Fundus photo. Image size 2352x1568.
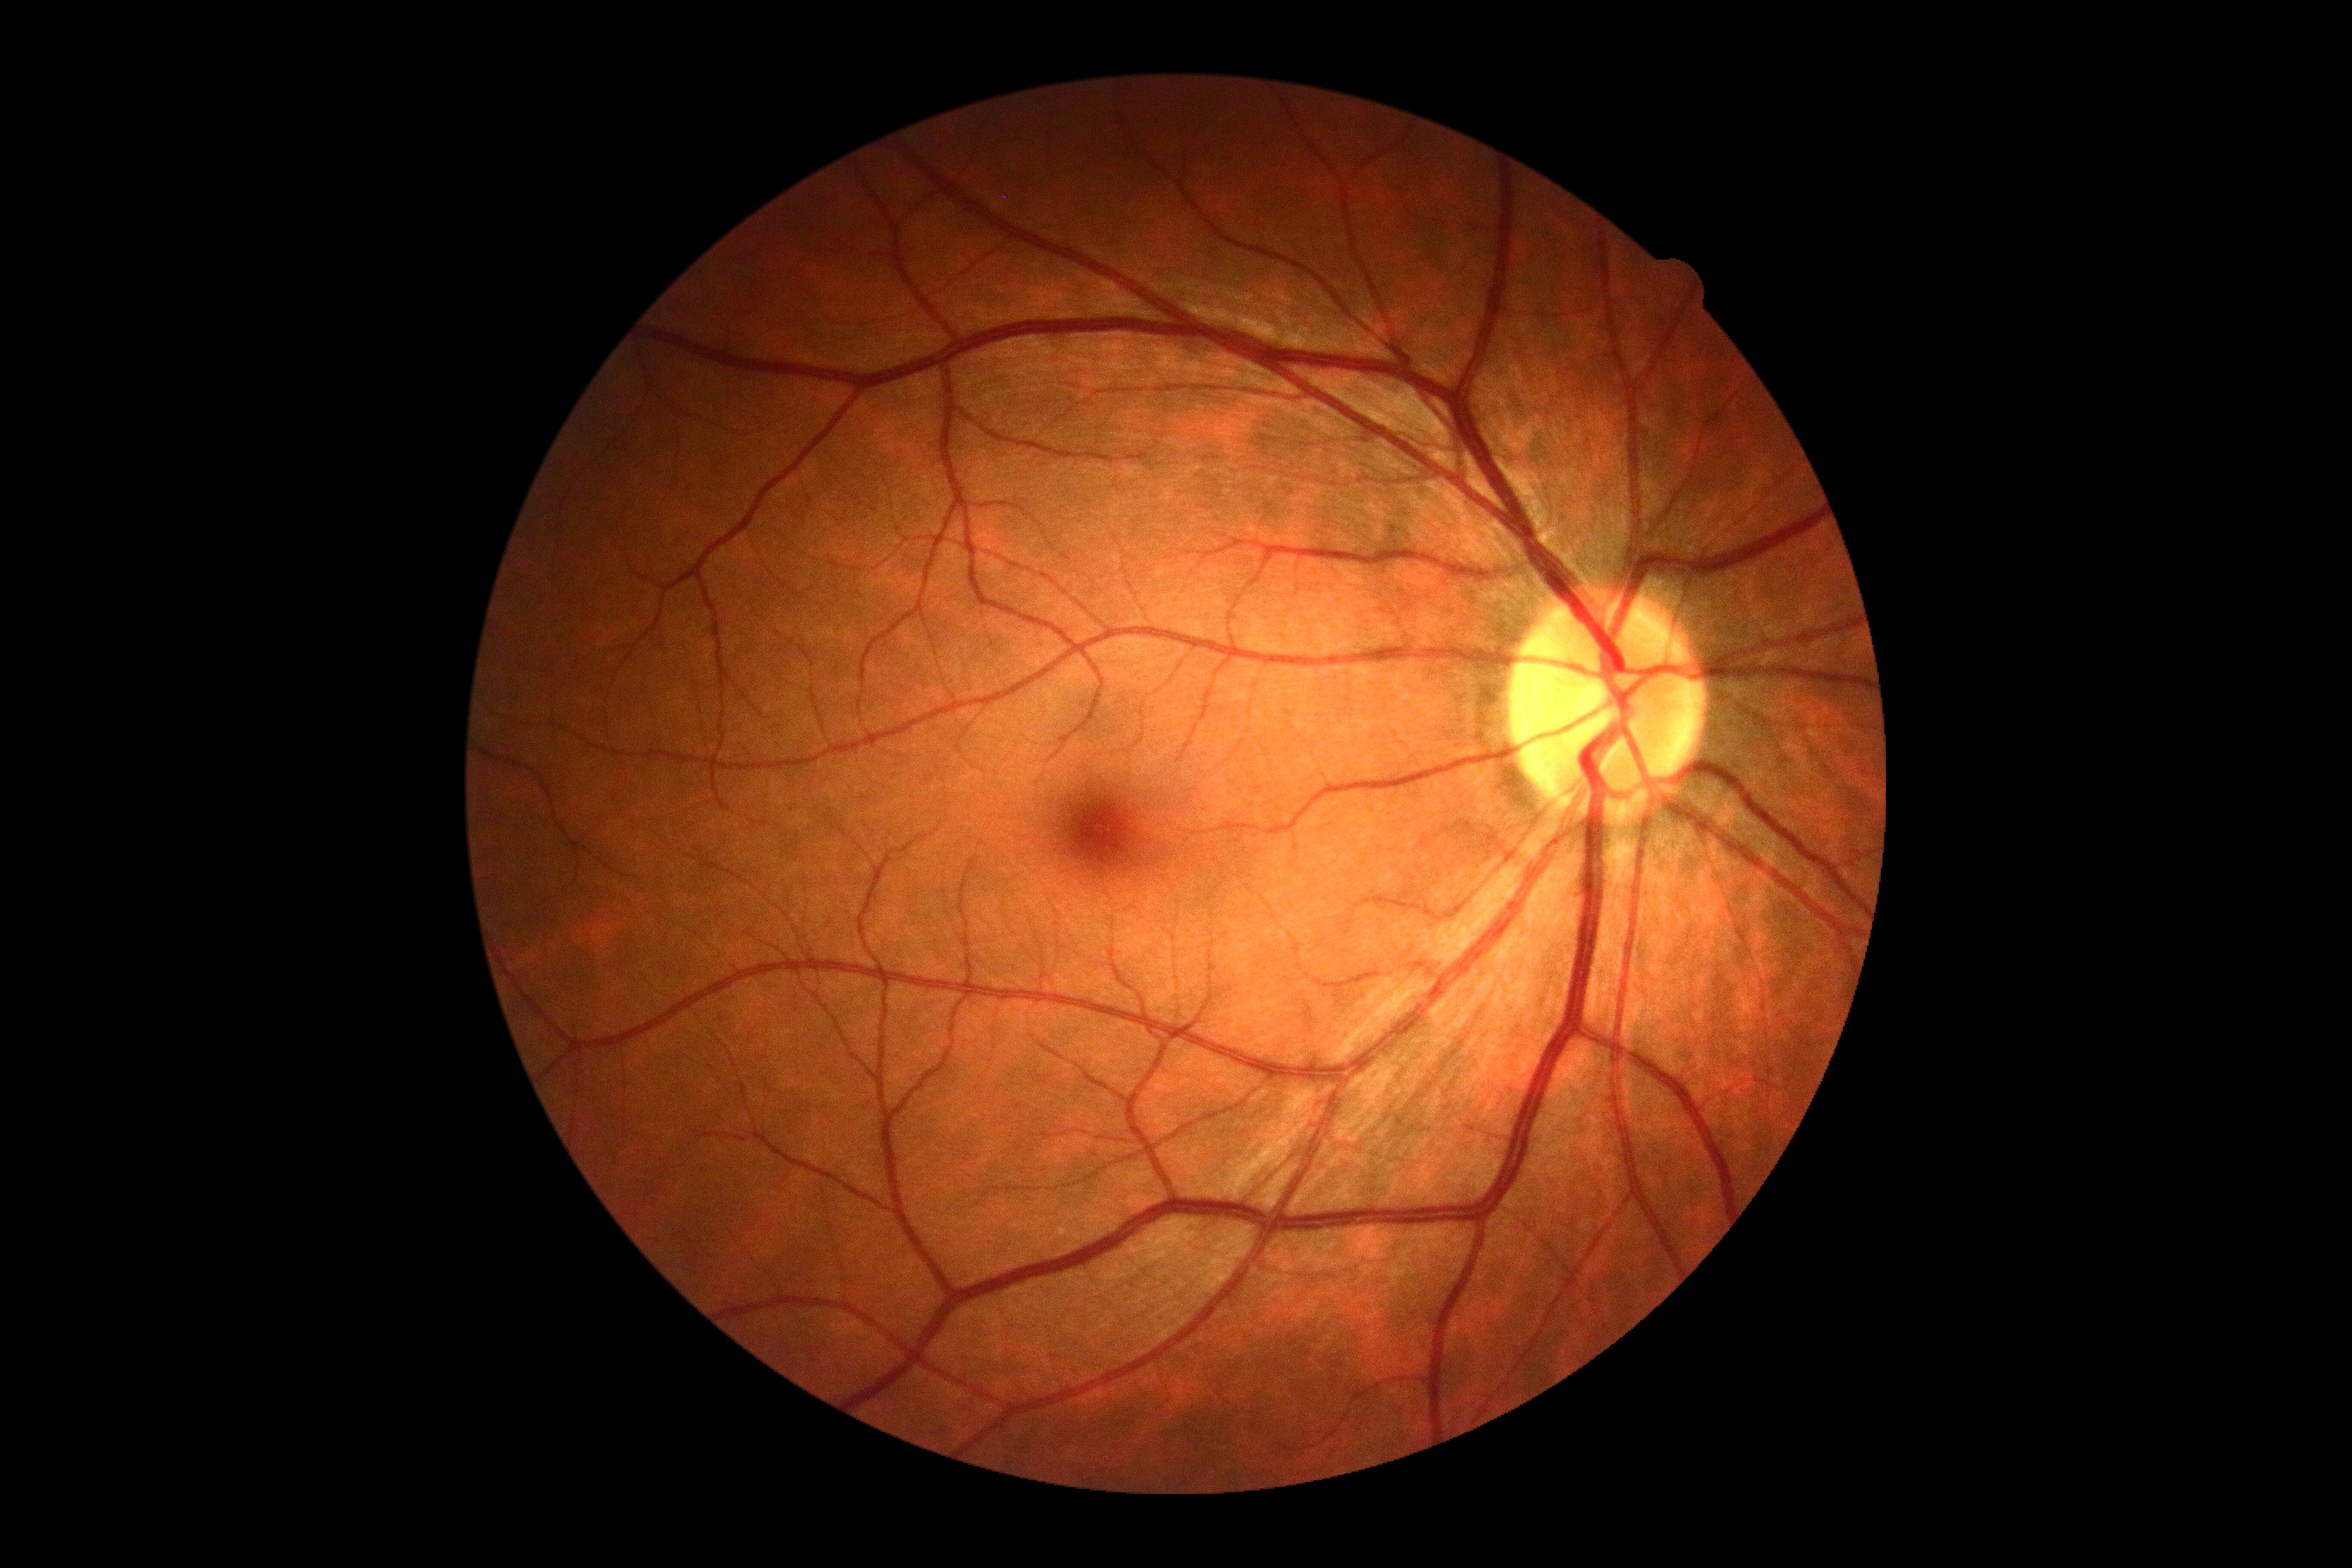

Findings:
- diabetic retinopathy (DR): no apparent retinopathy (grade 0)